45° field of view · acquired with a NIDEK AFC-230: 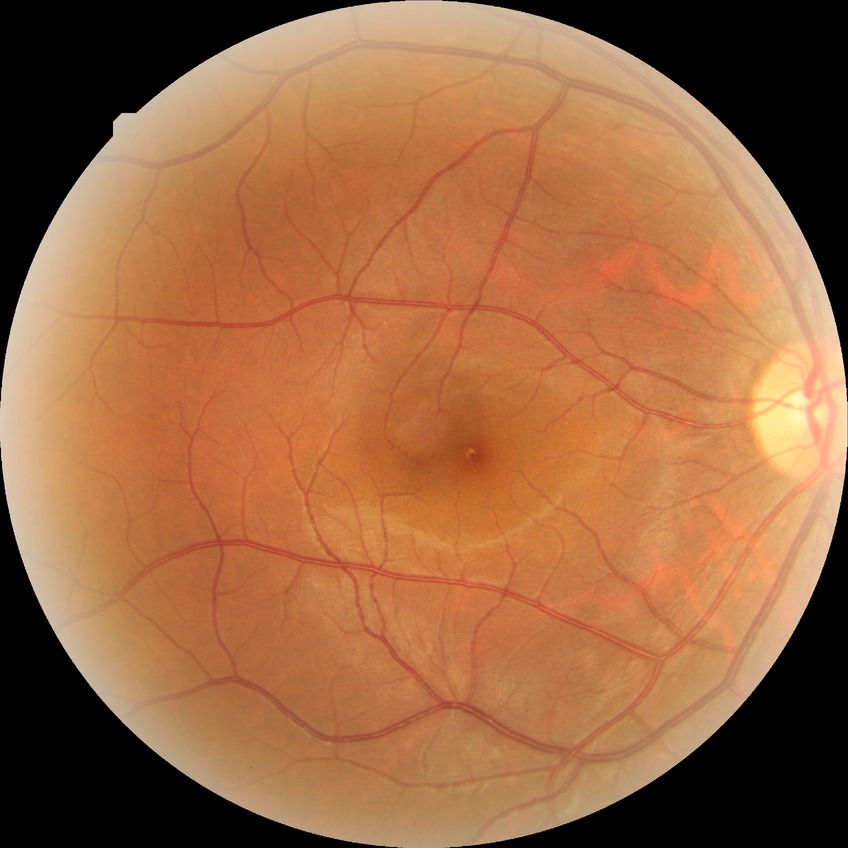
Diabetic retinopathy (DR) is NDR (no diabetic retinopathy).